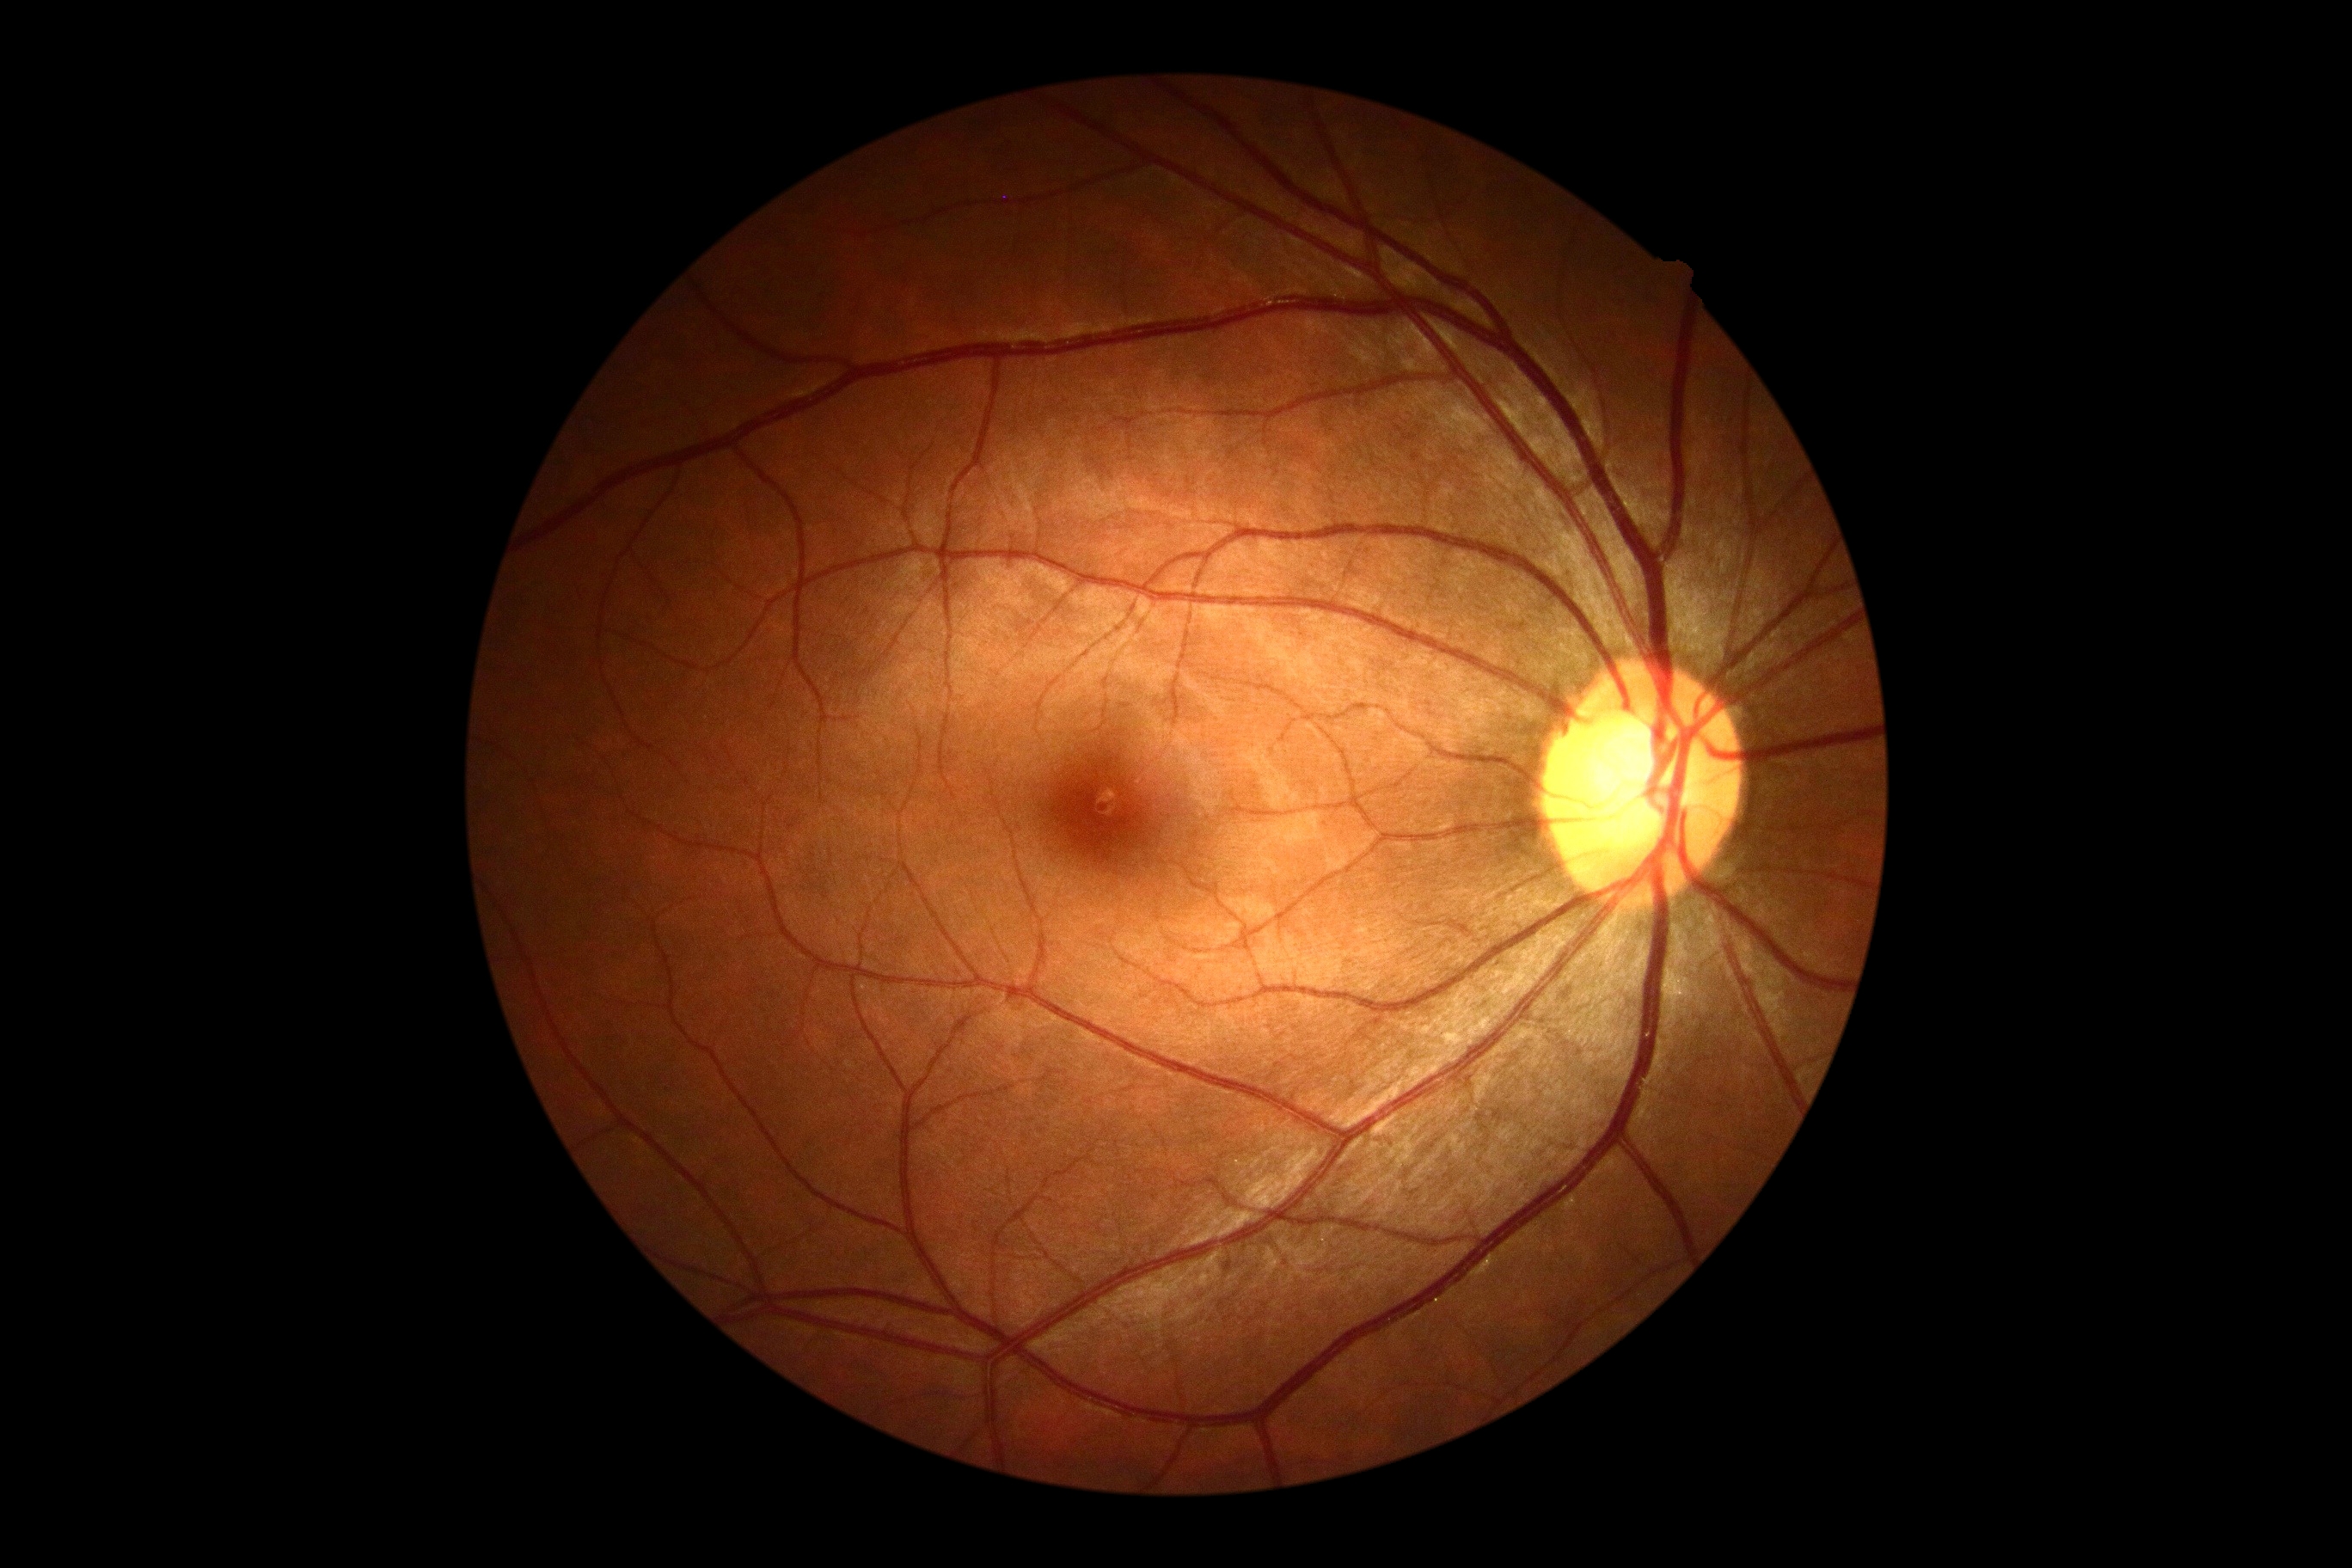
Diabetic retinopathy (DR): grade 0 (no apparent retinopathy).